Acquired with a Topcon TRC-NW400. Fundus photo. Corneal thickness 600 µm. 74 years old:
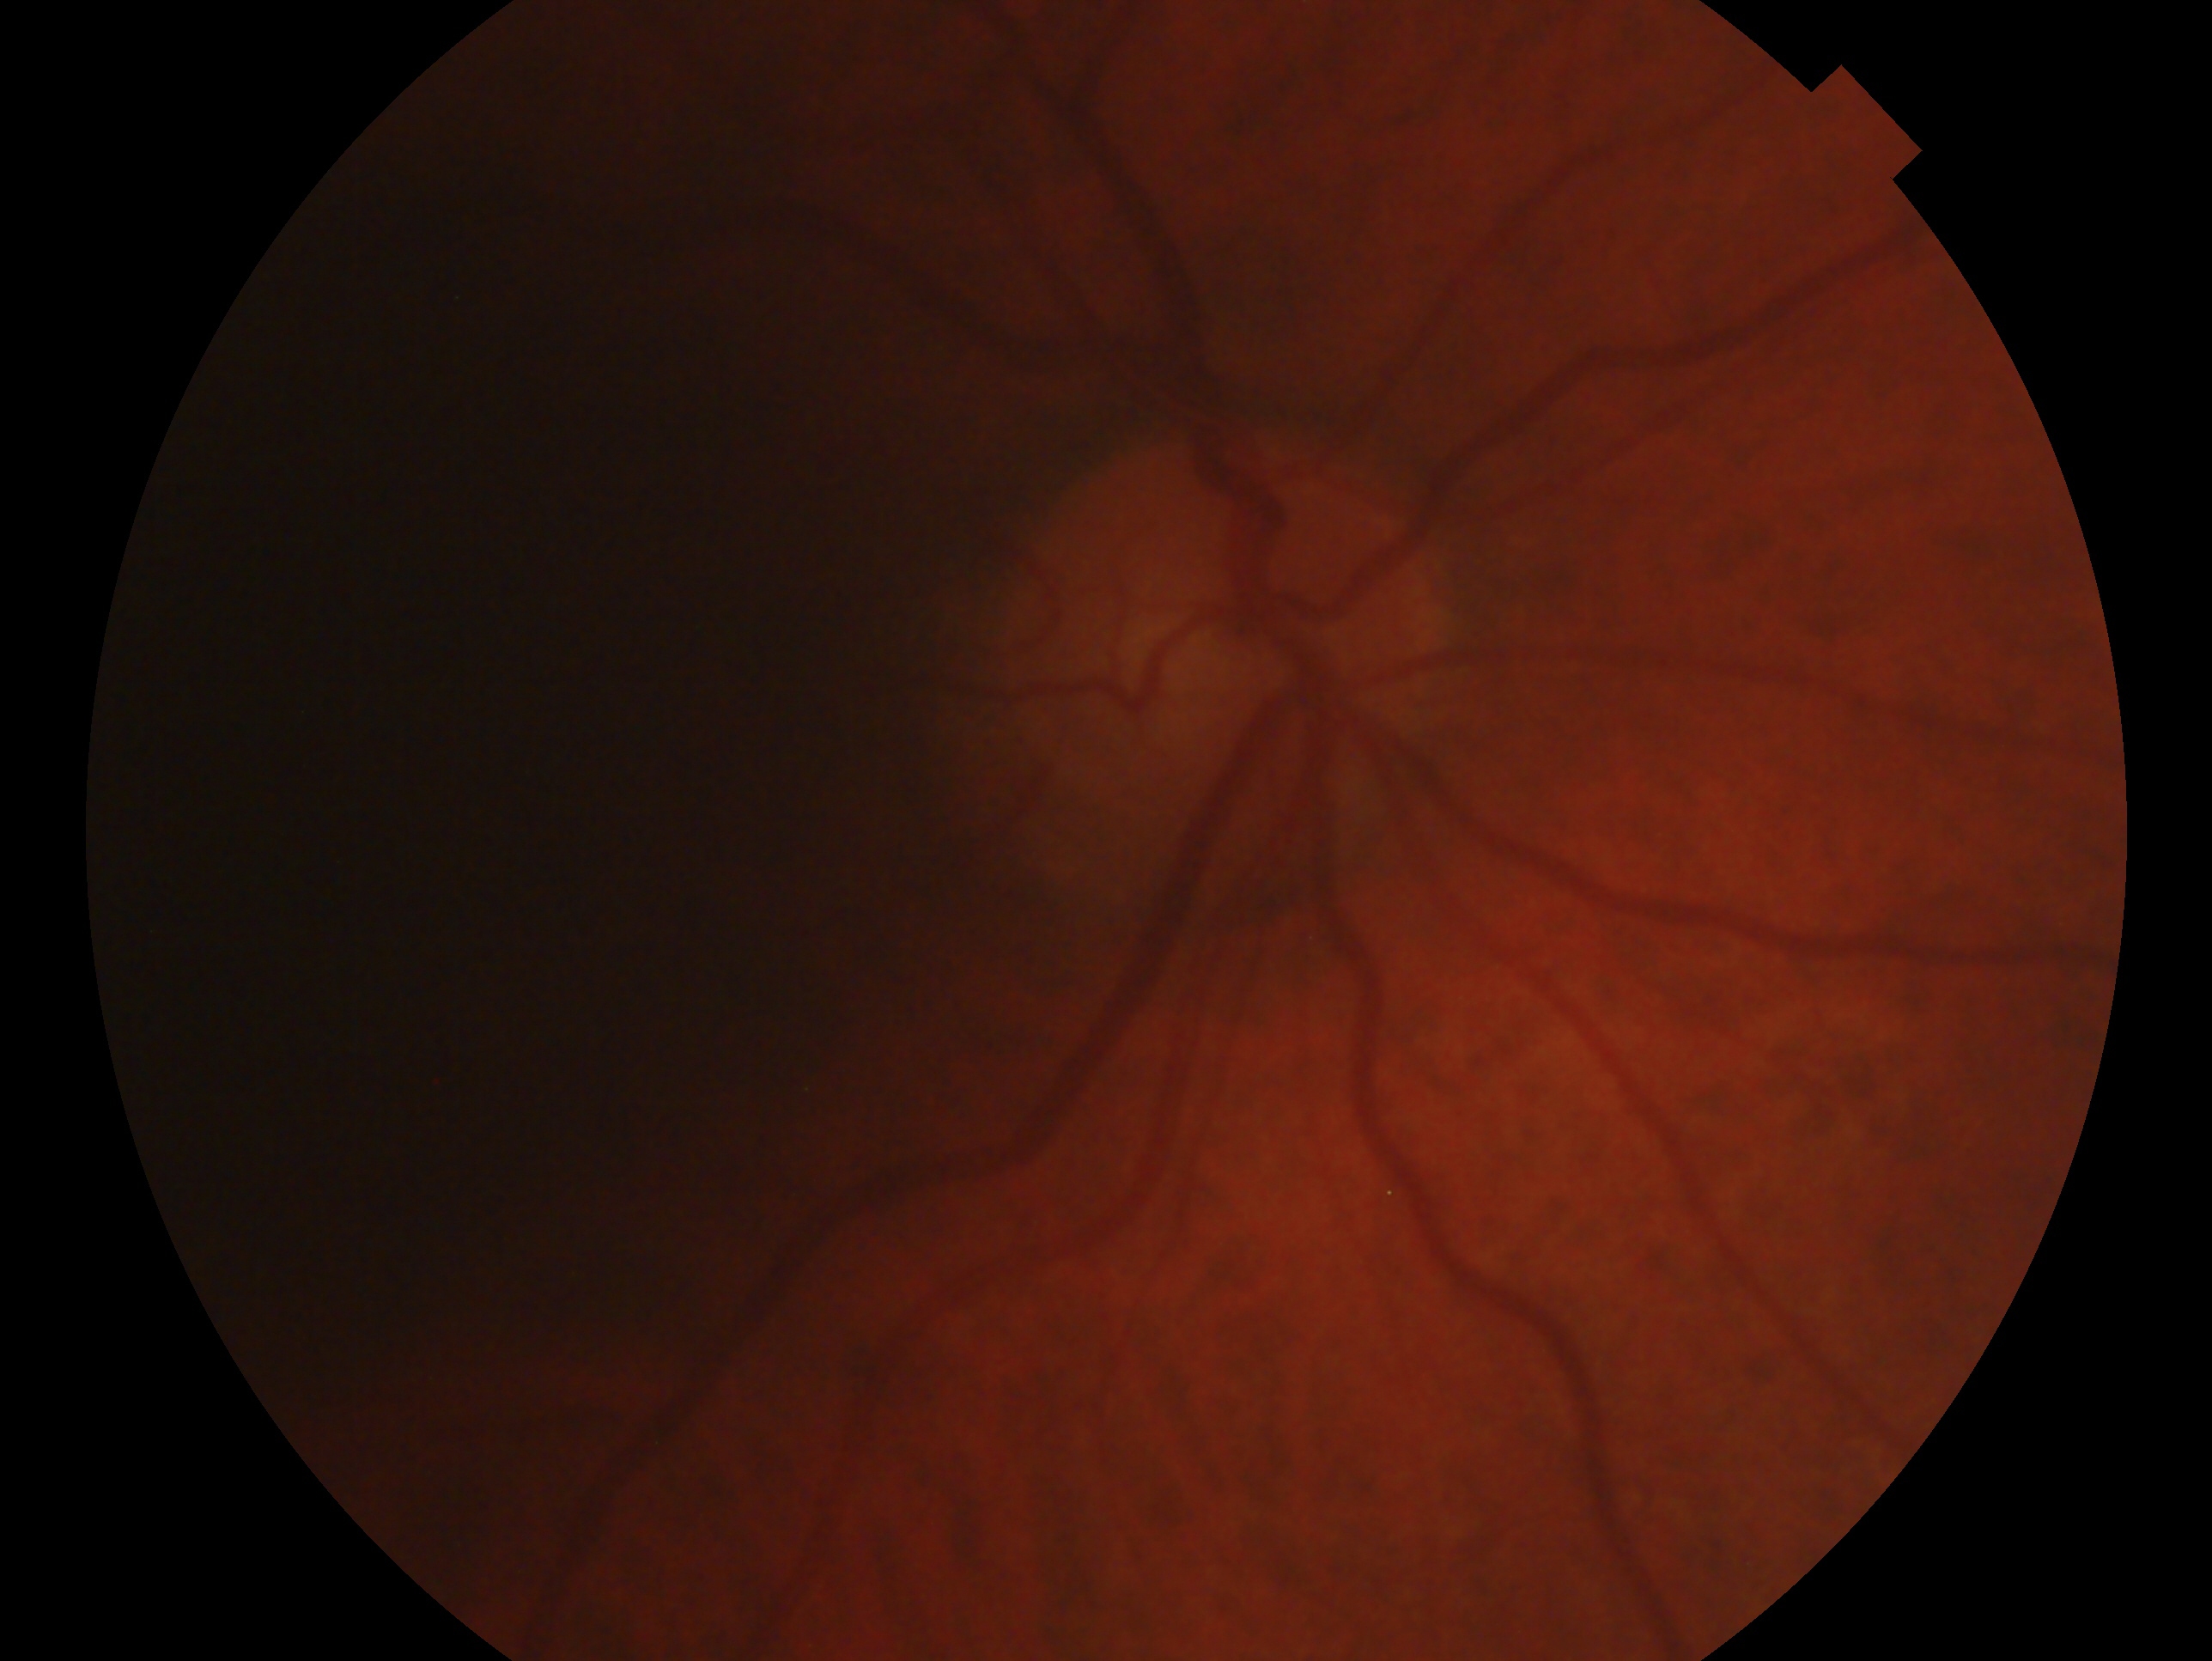

Glaucoma diagnosis: no glaucoma. Imaged eye: OD.